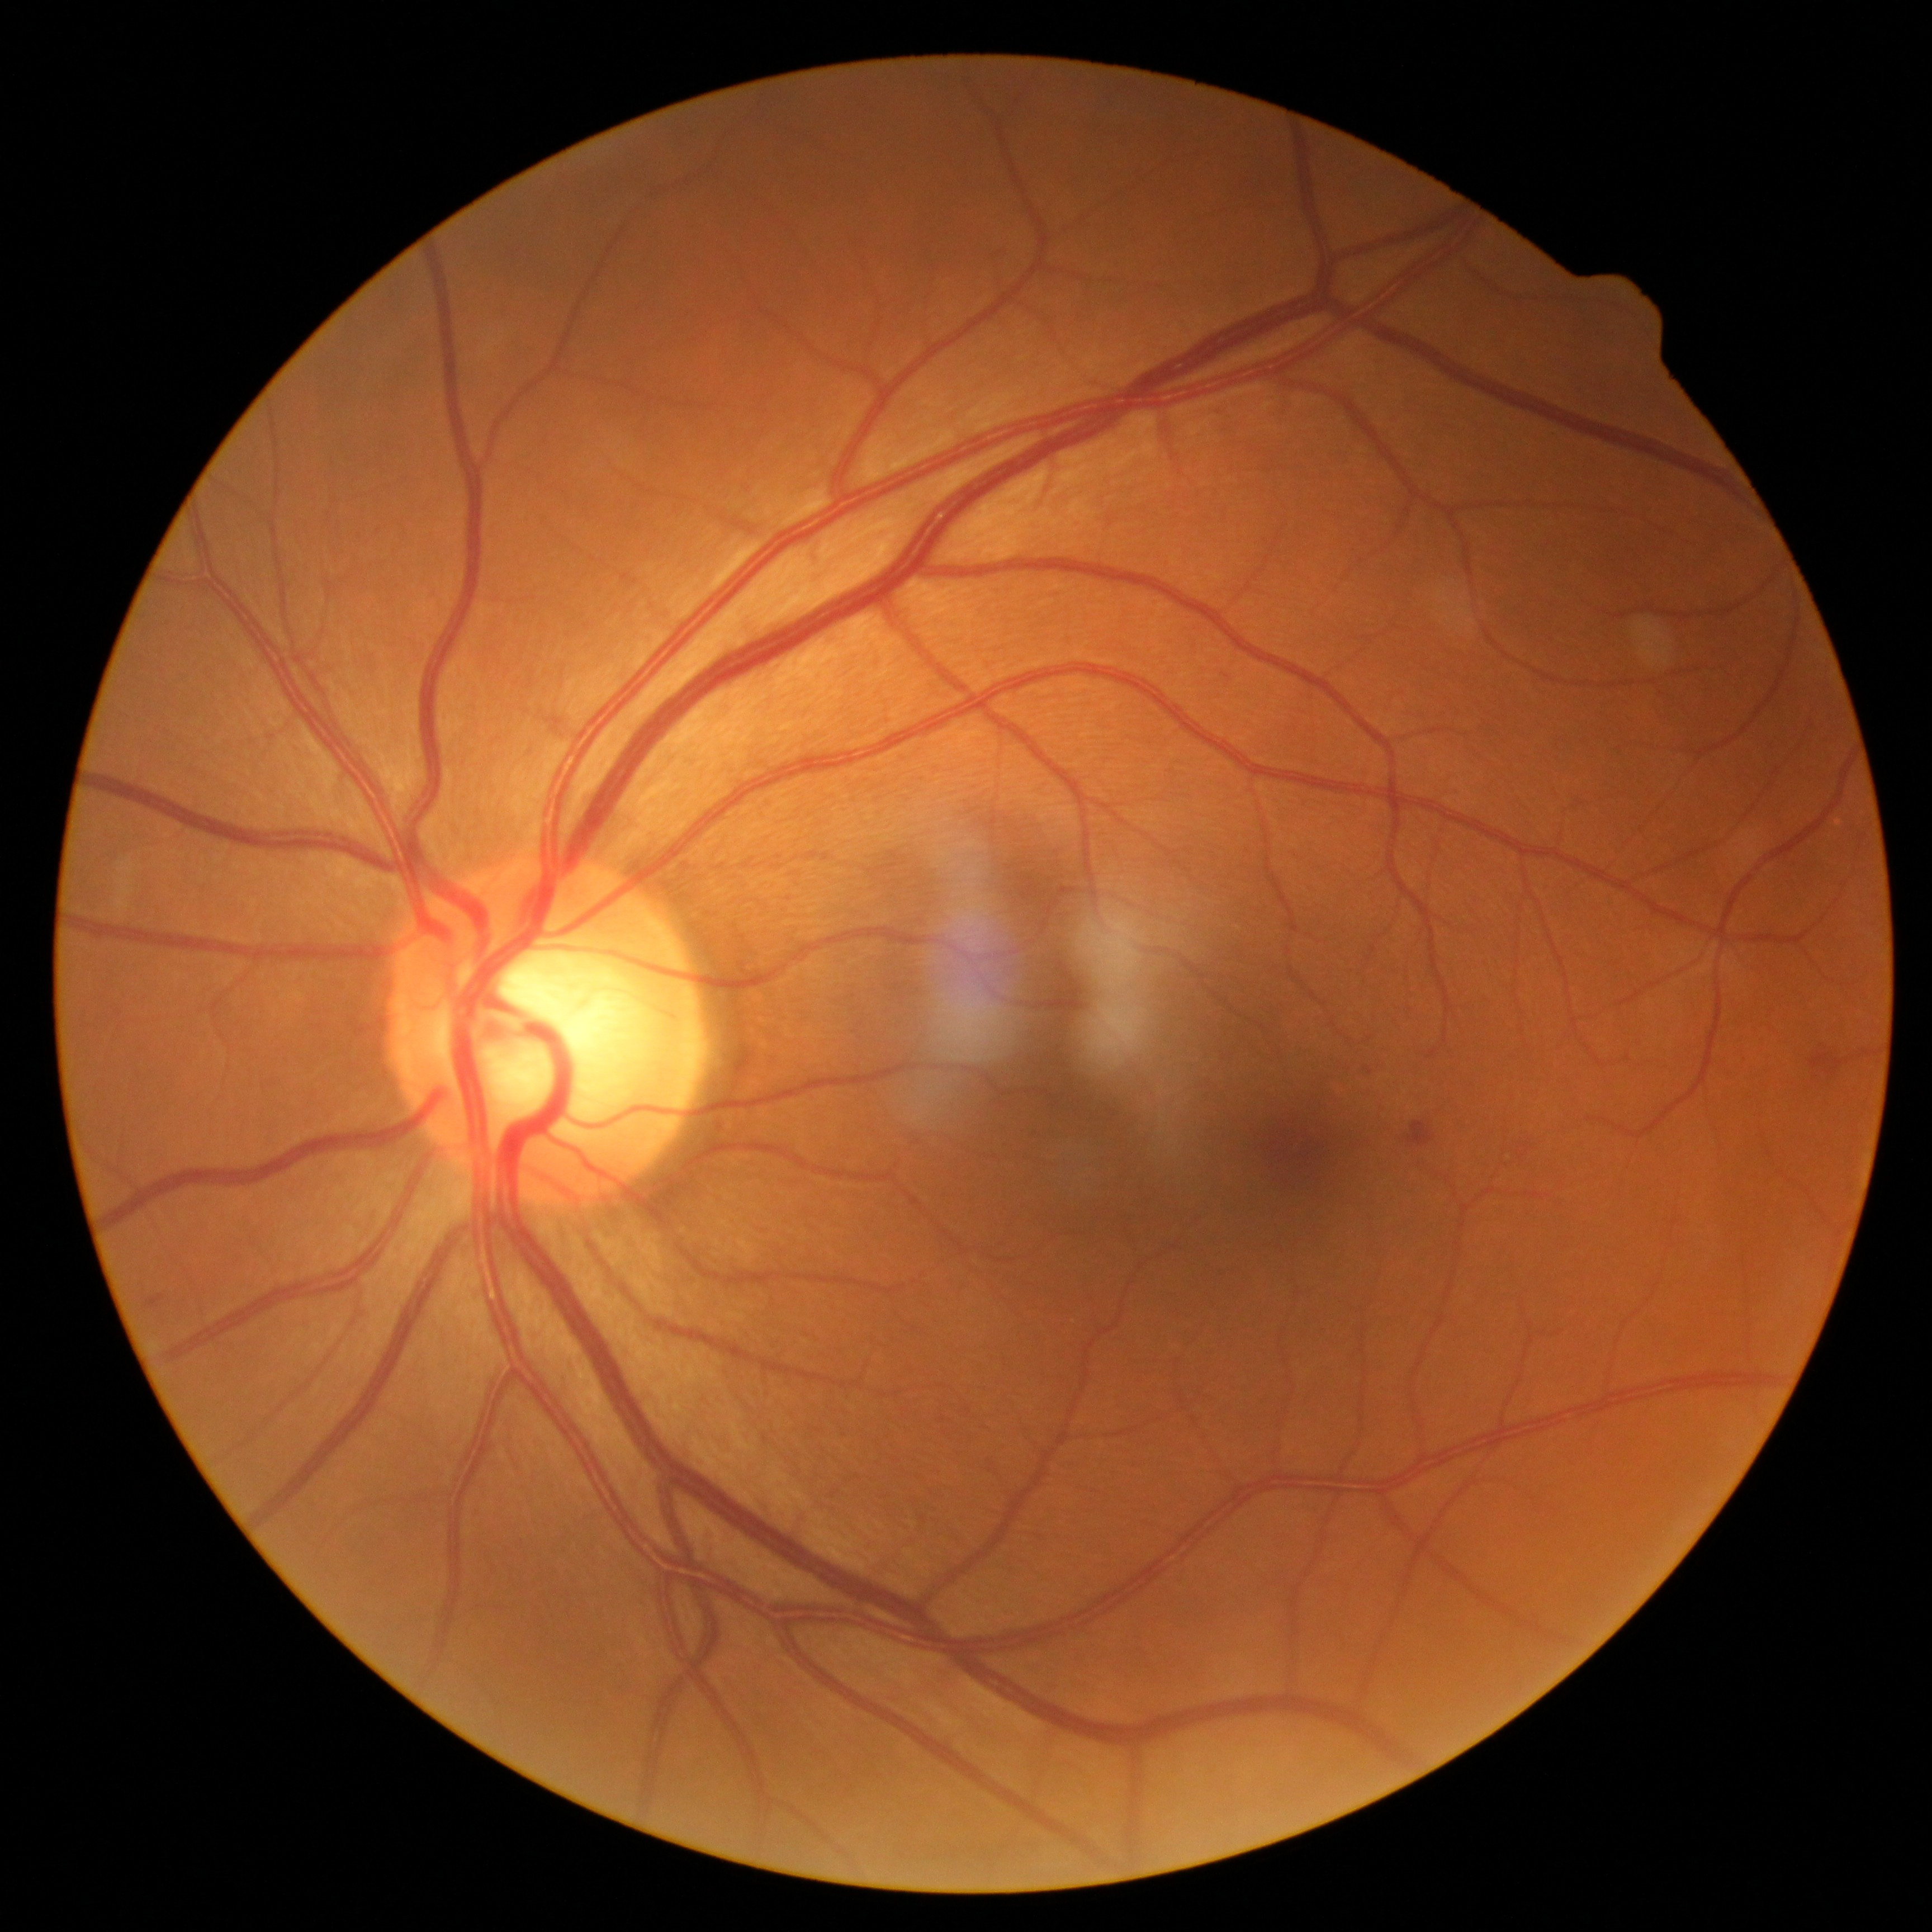
Diabetic retinopathy (DR) is moderate NPDR (grade 2).